Pediatric wide-field fundus photograph — 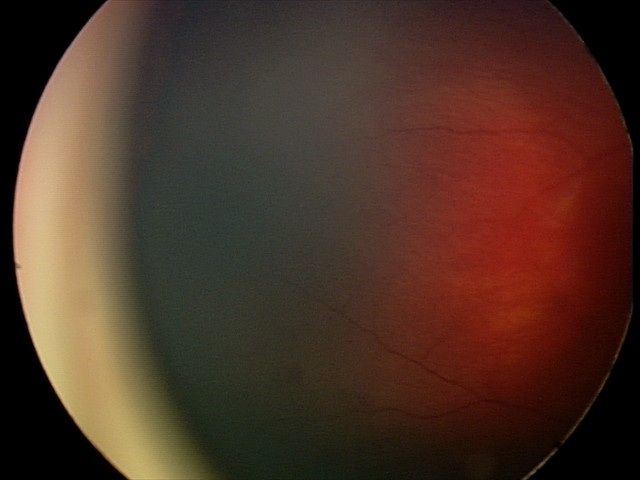

Screening diagnosis: retinal hemorrhages.